Fundus image cropped to the optic disc:
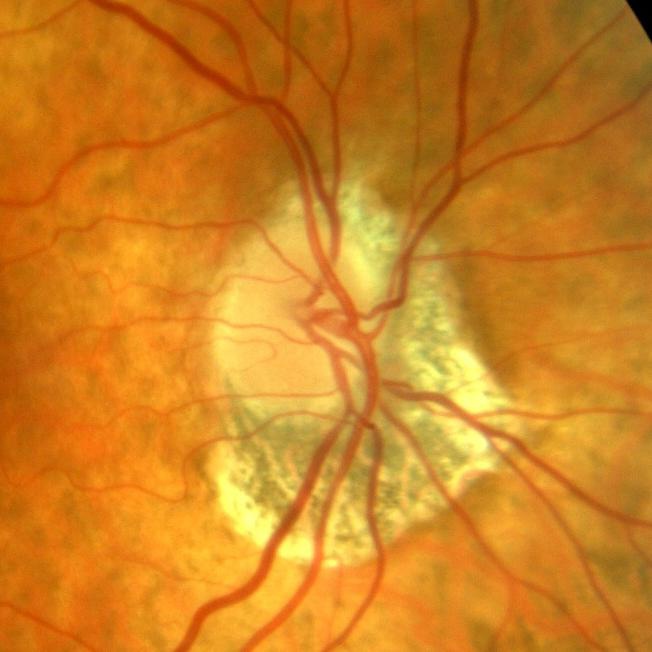
Showing no glaucoma.